1932x1932px, acquired with a Topcon TRC-NW8:
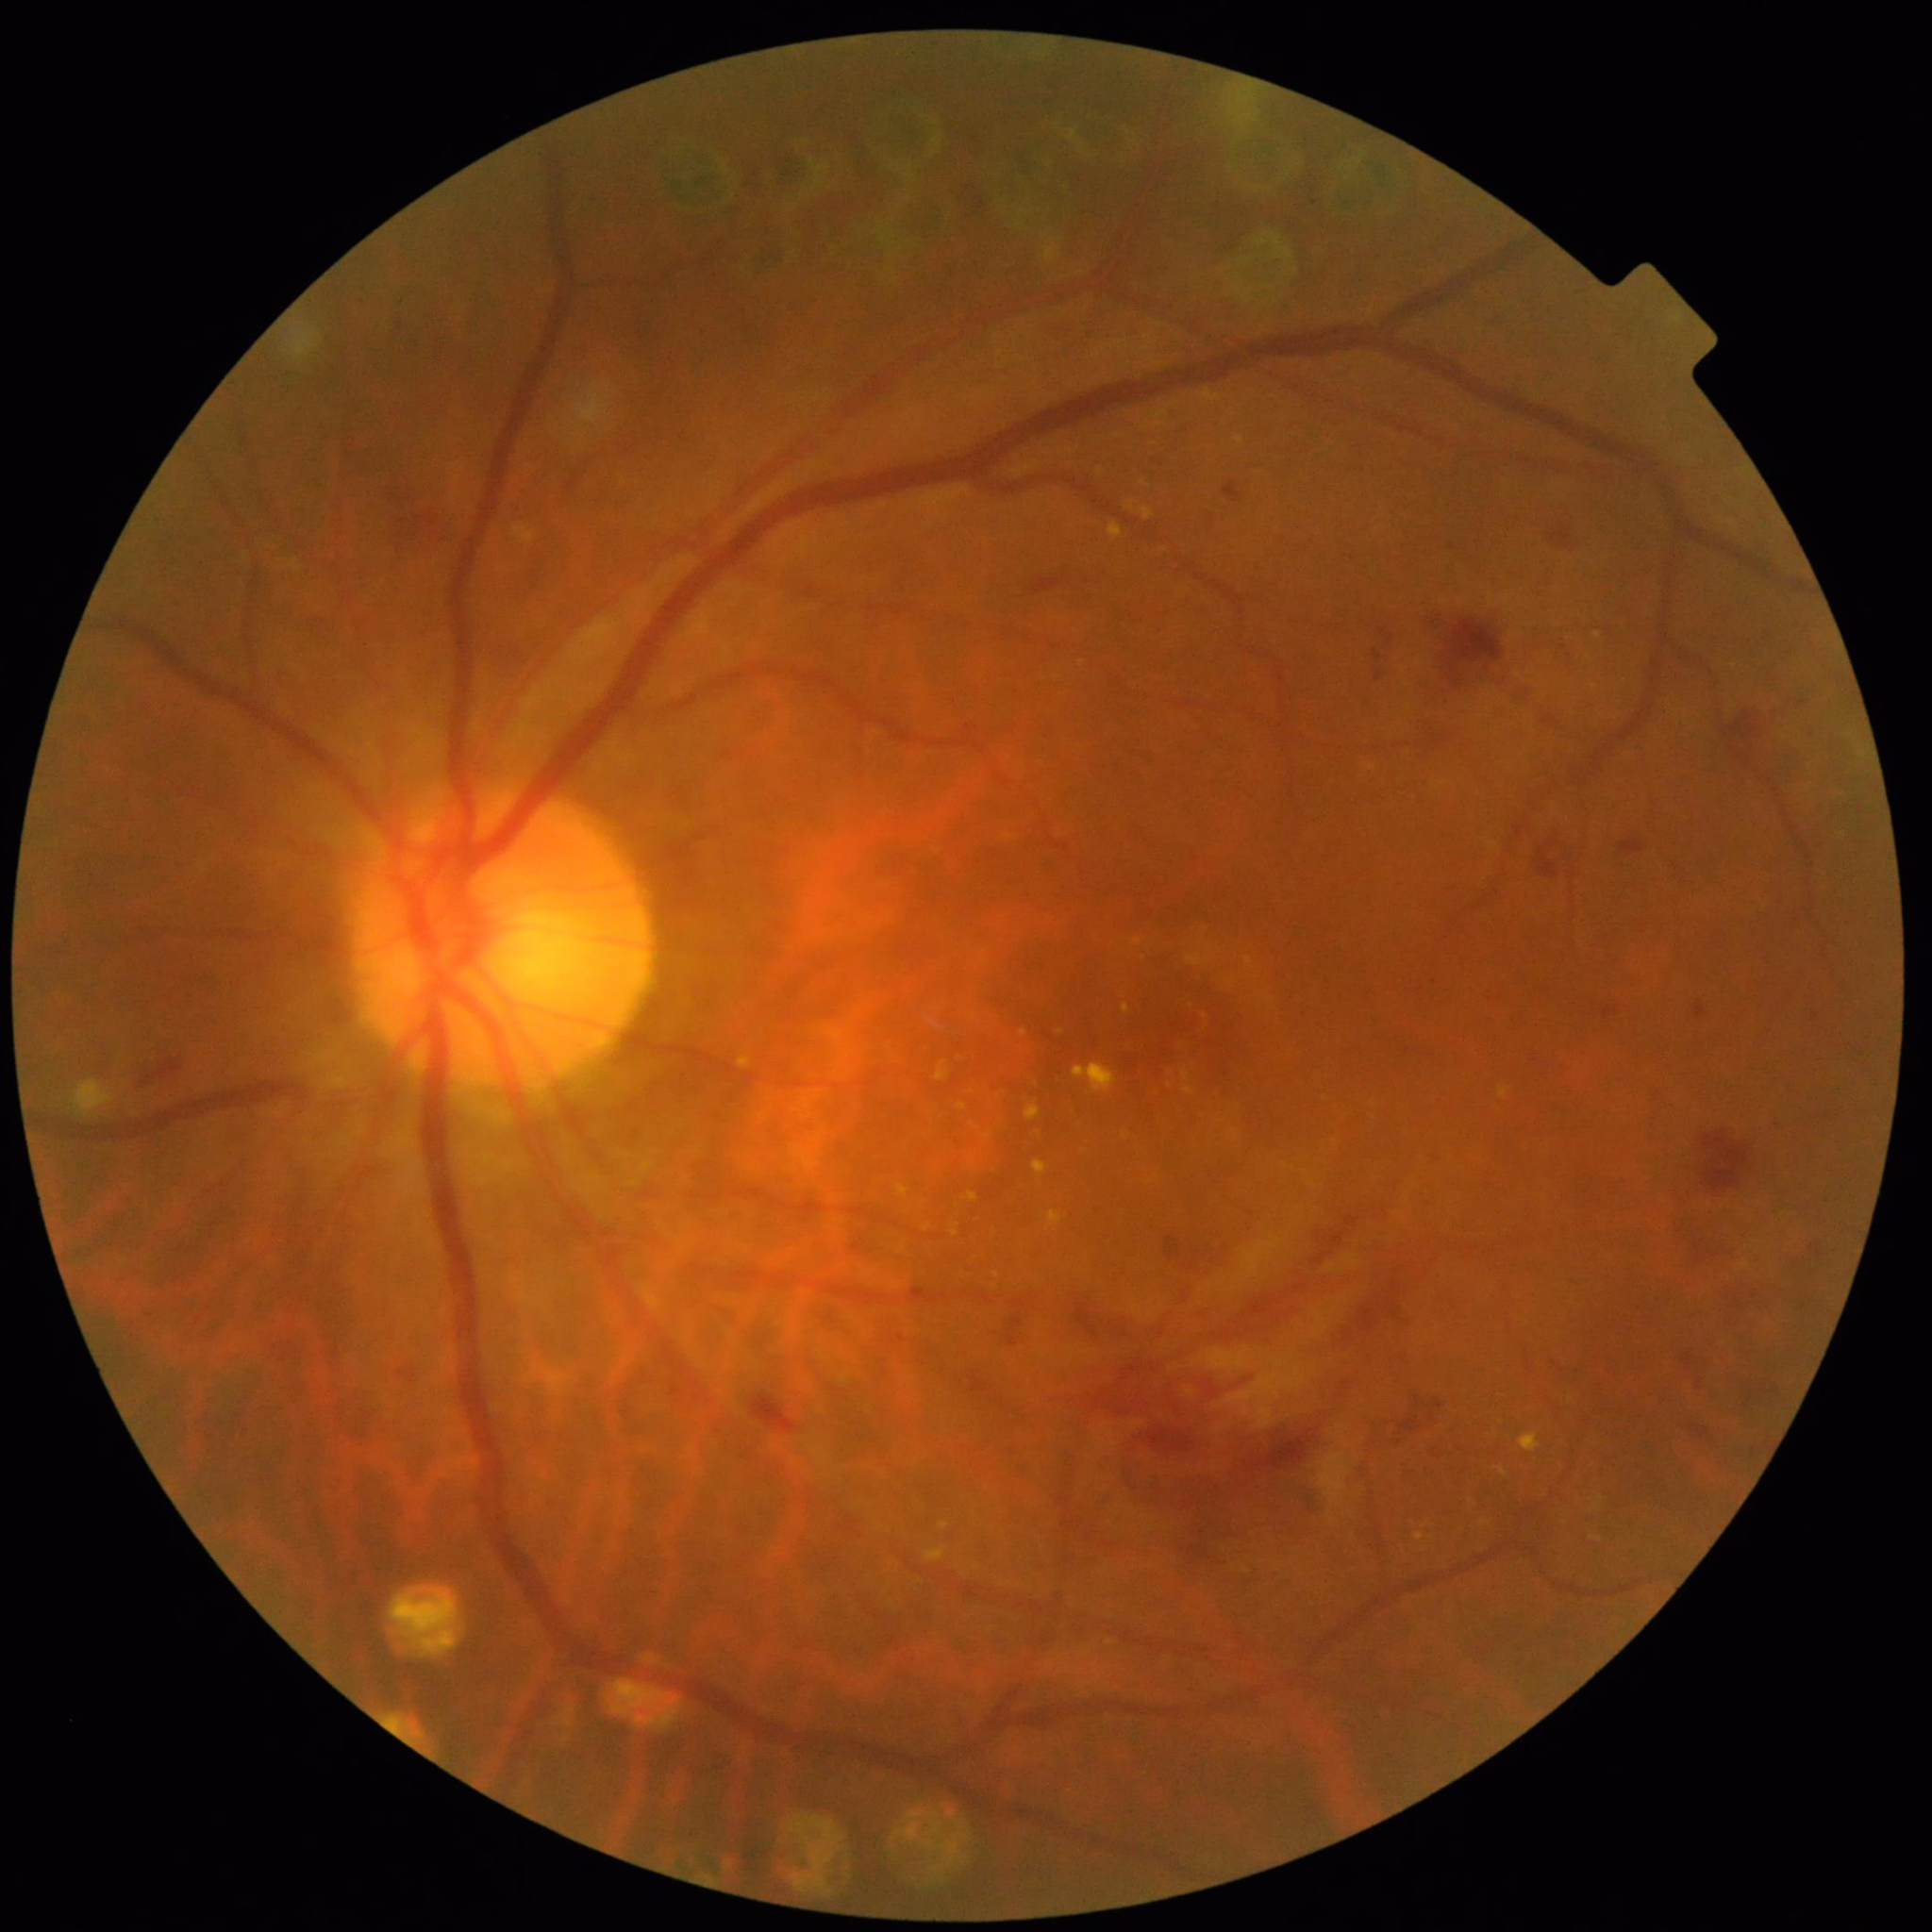
{
  "diagnosis": "DR",
  "image_quality": "good"
}